Fundus photo; 45° field of view; 2184 x 1690 pixels.
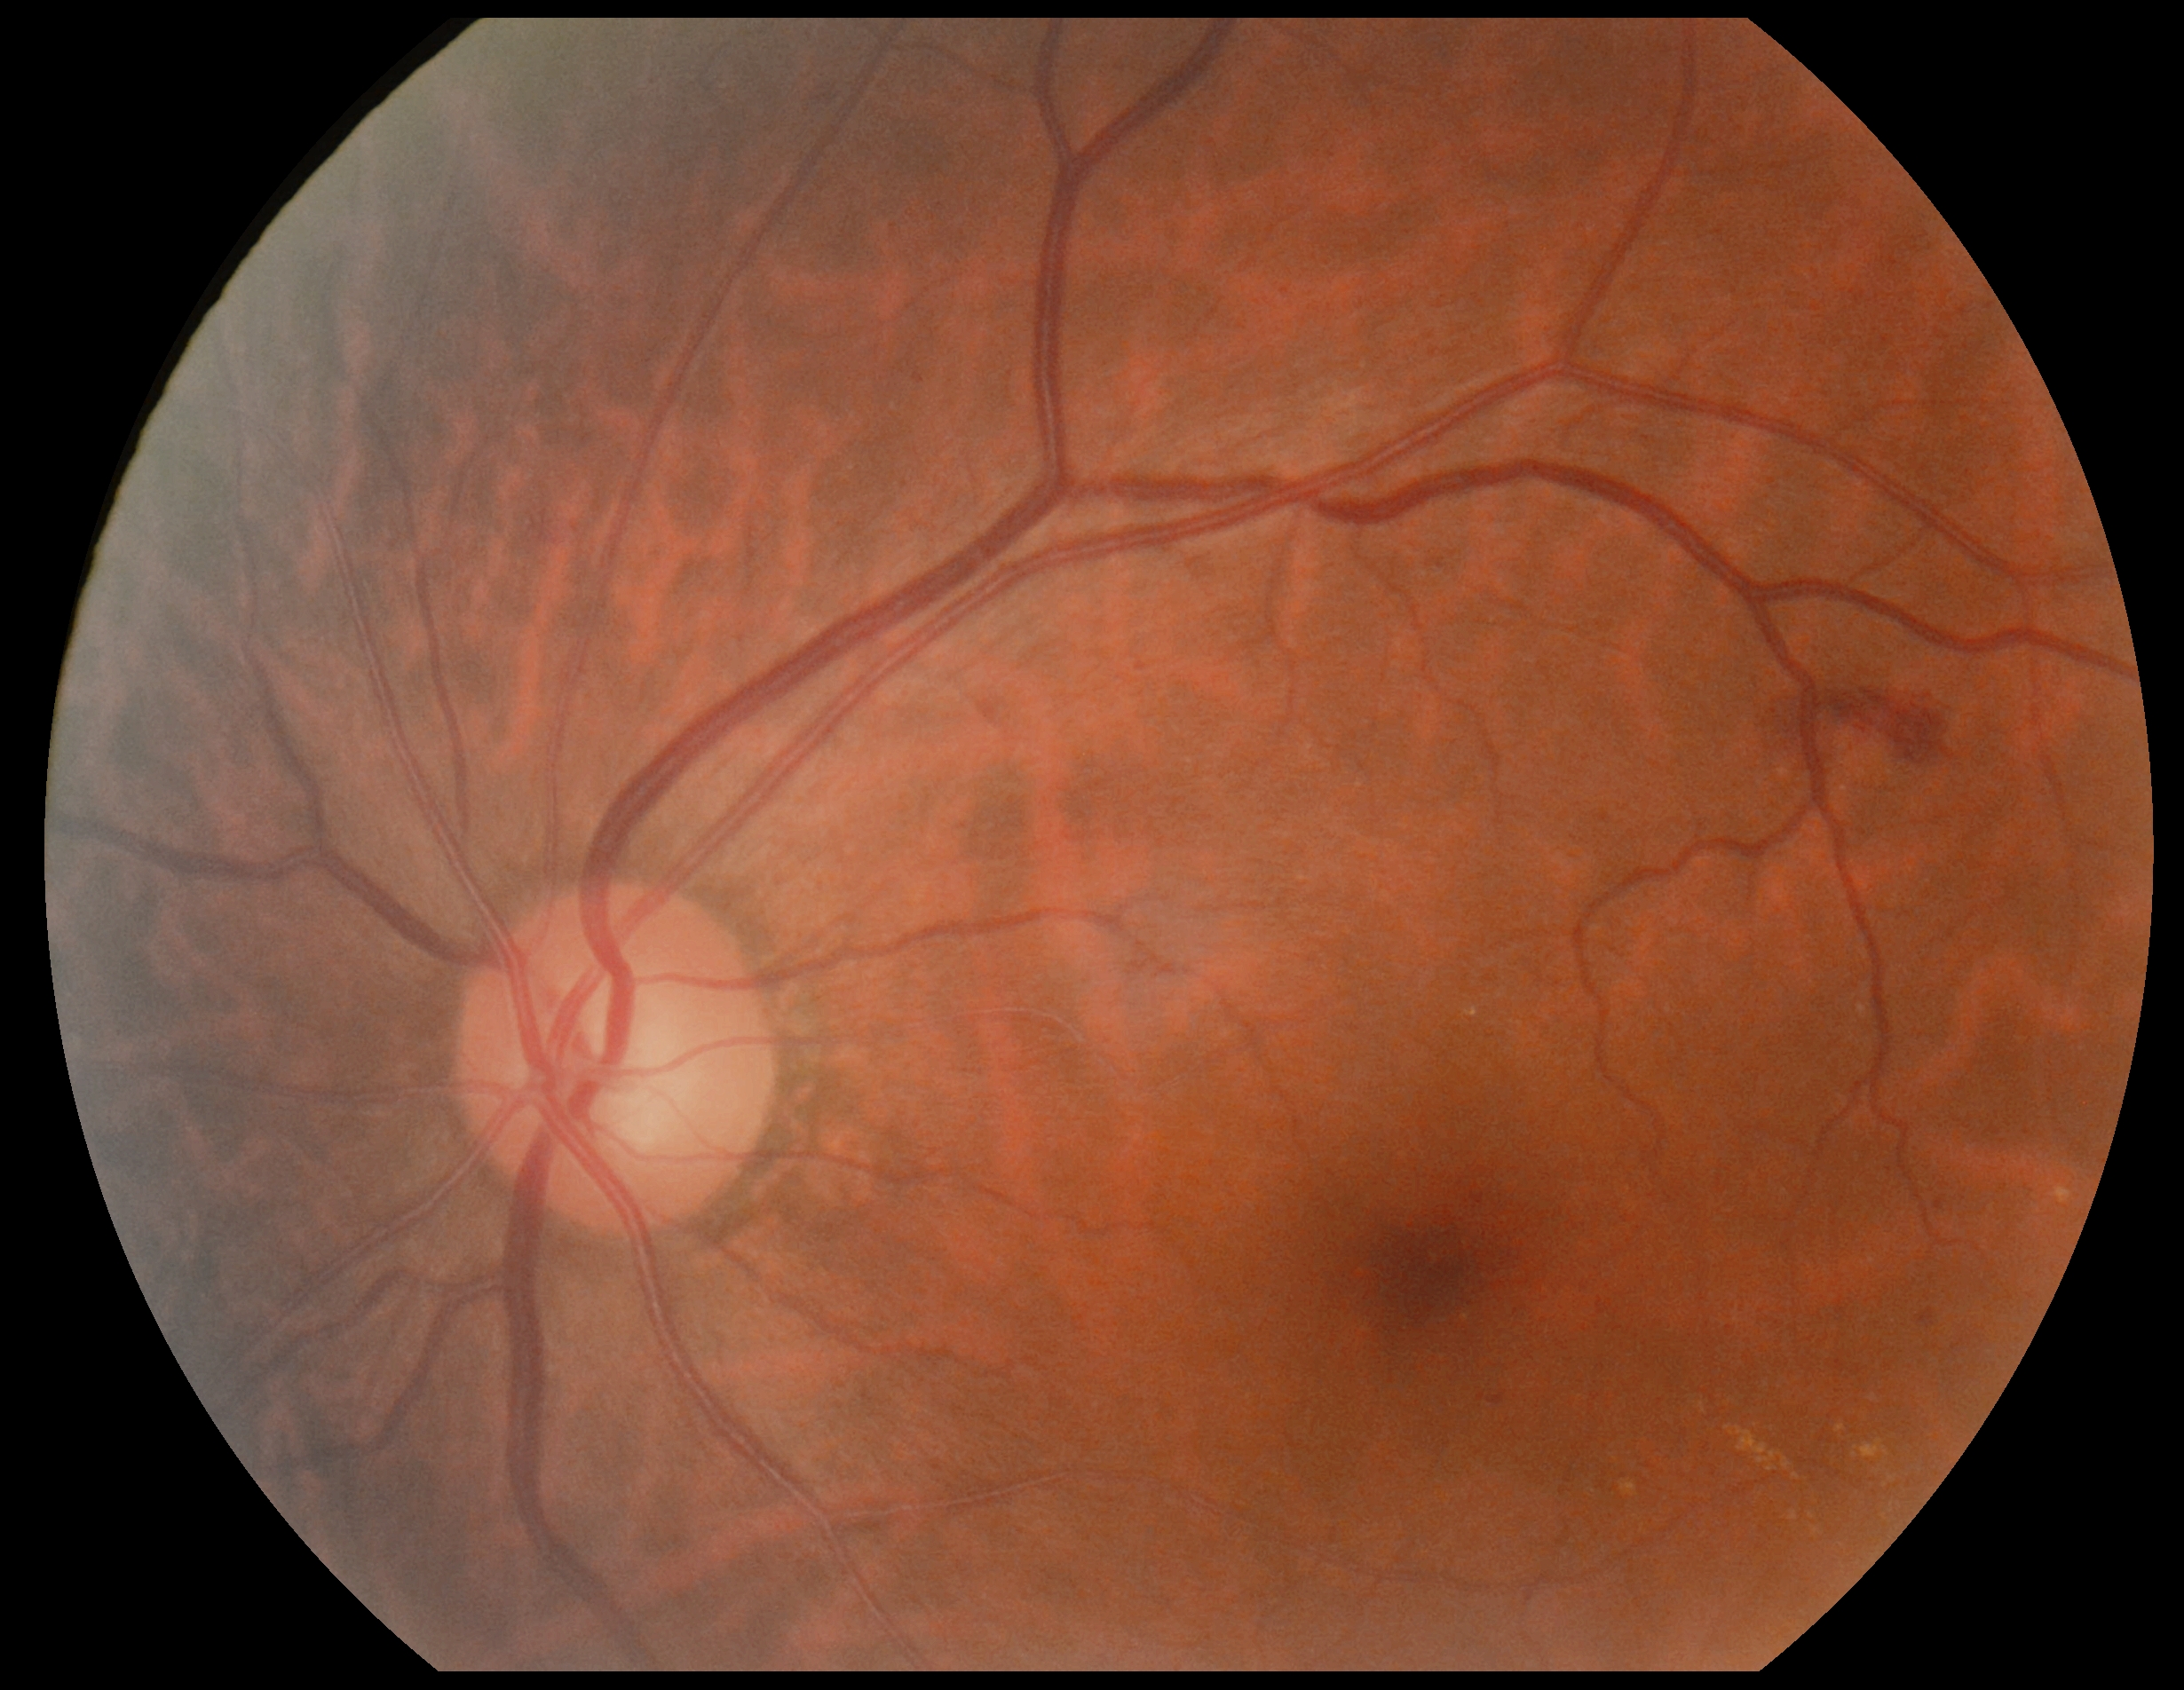

DR grade: 2 (moderate NPDR)